1240x1240px · Phoenix ICON, 100° FOV · wide-field fundus photograph from neonatal ROP screening: 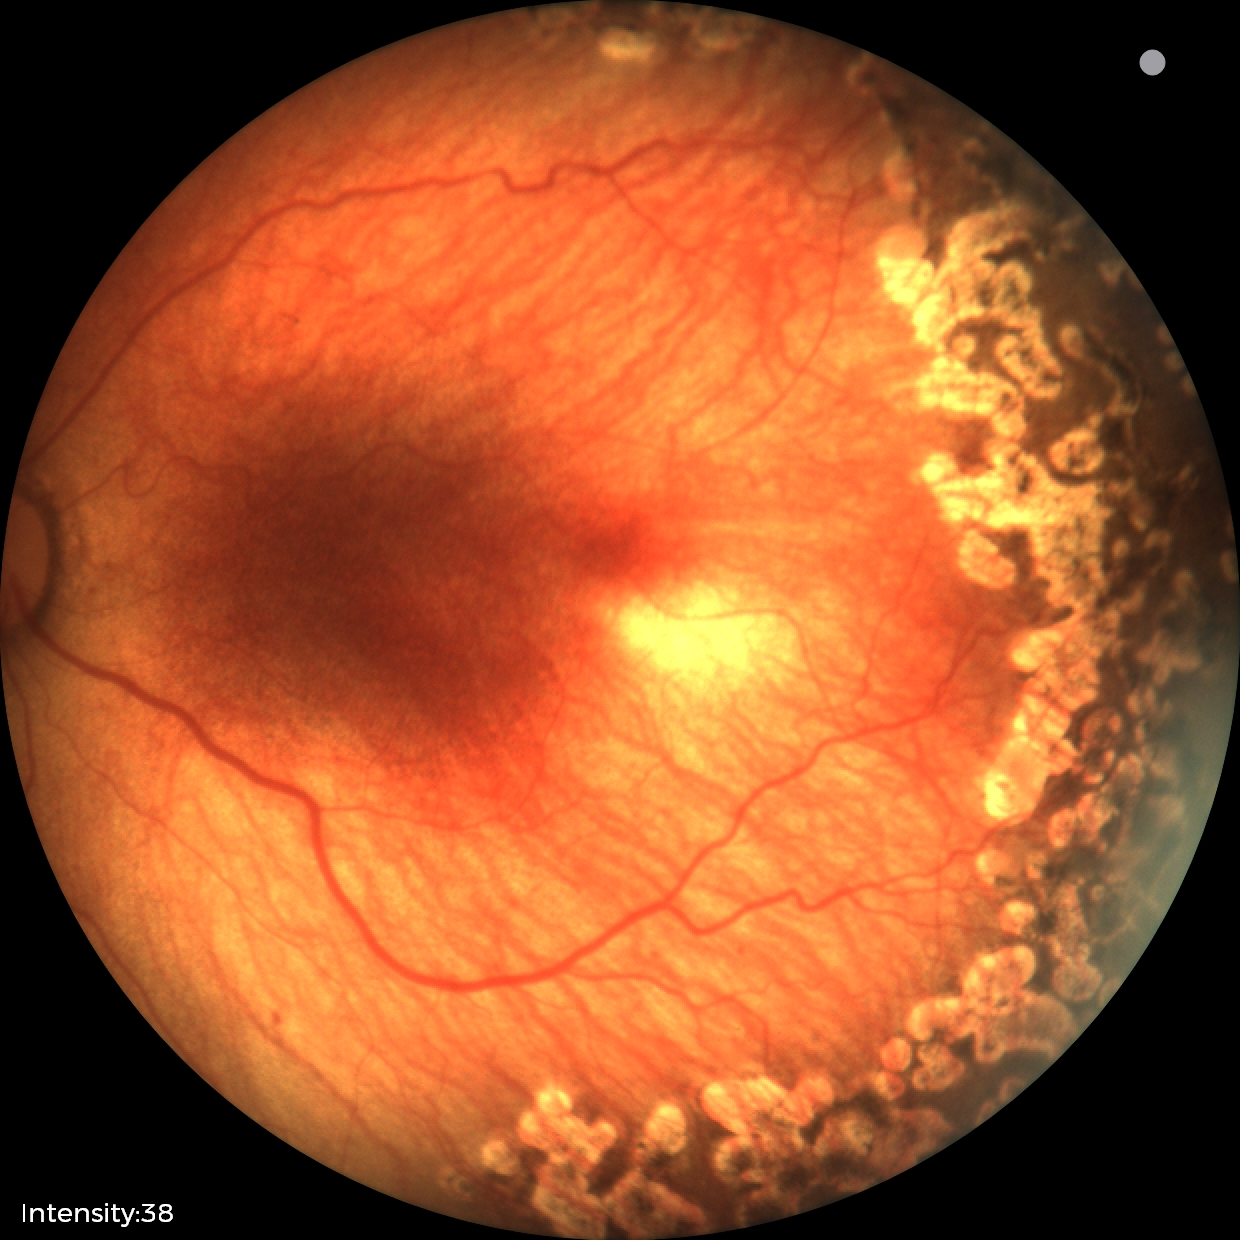
Impression: no plus disease; status post retinopathy of prematurity (ROP).